1240 by 1240 pixels; wide-field fundus image from infant ROP screening; 100° field of view (Phoenix ICON): 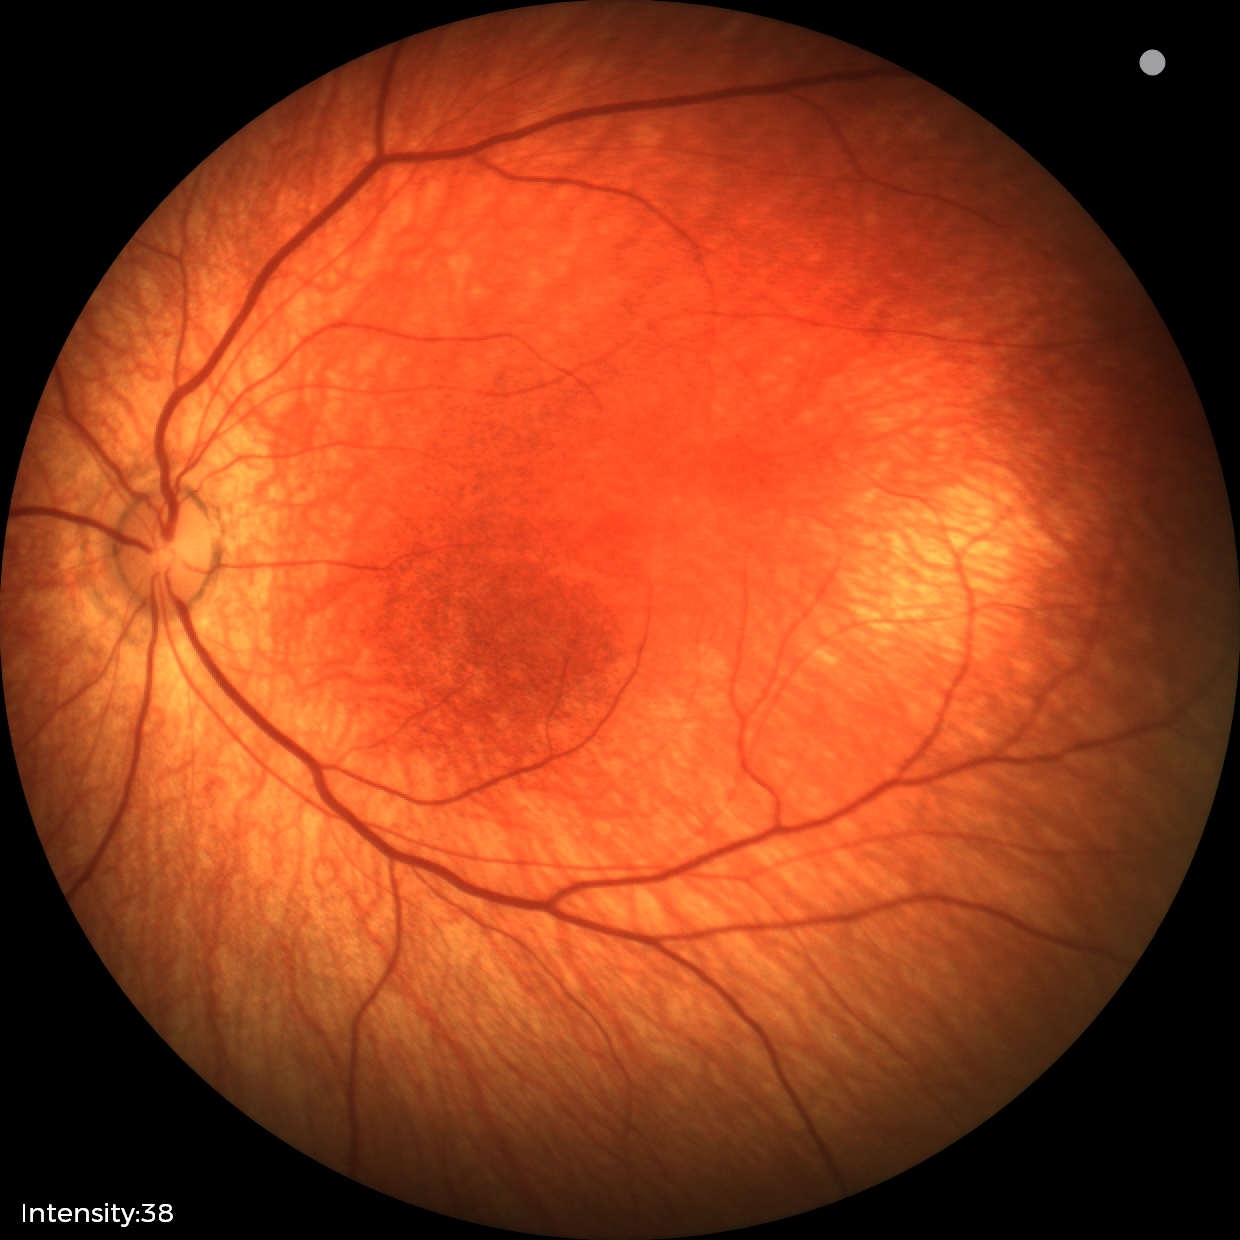 Physiological retinal appearance for postconceptual age.